FOV: 45 degrees:
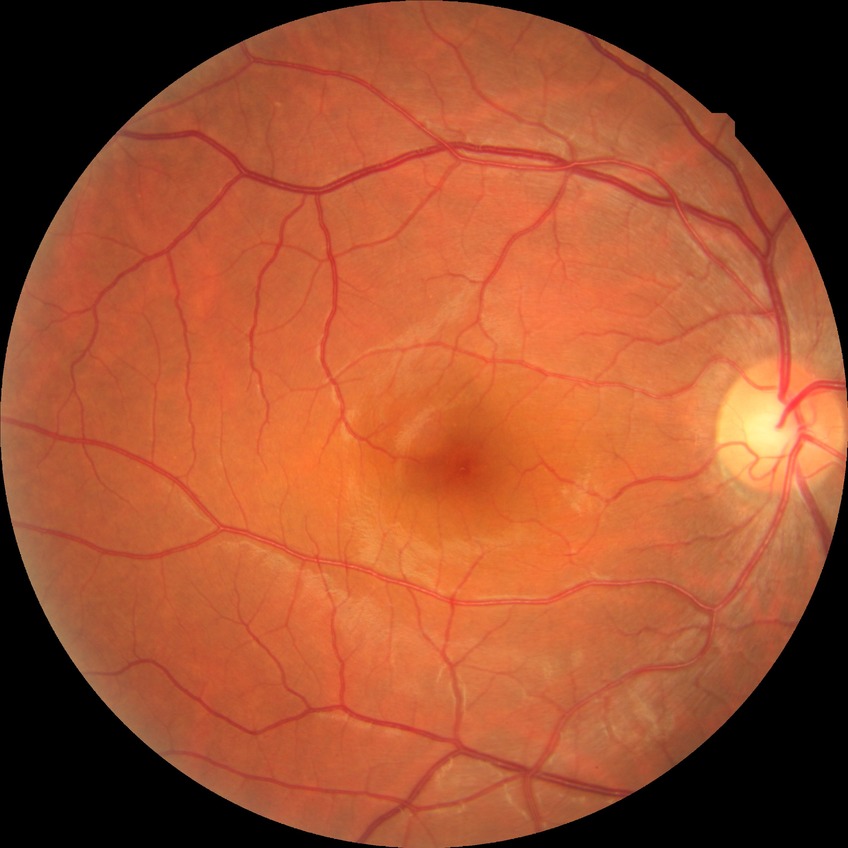
Diabetic retinopathy (DR): no diabetic retinopathy (NDR).